45-degree field of view — 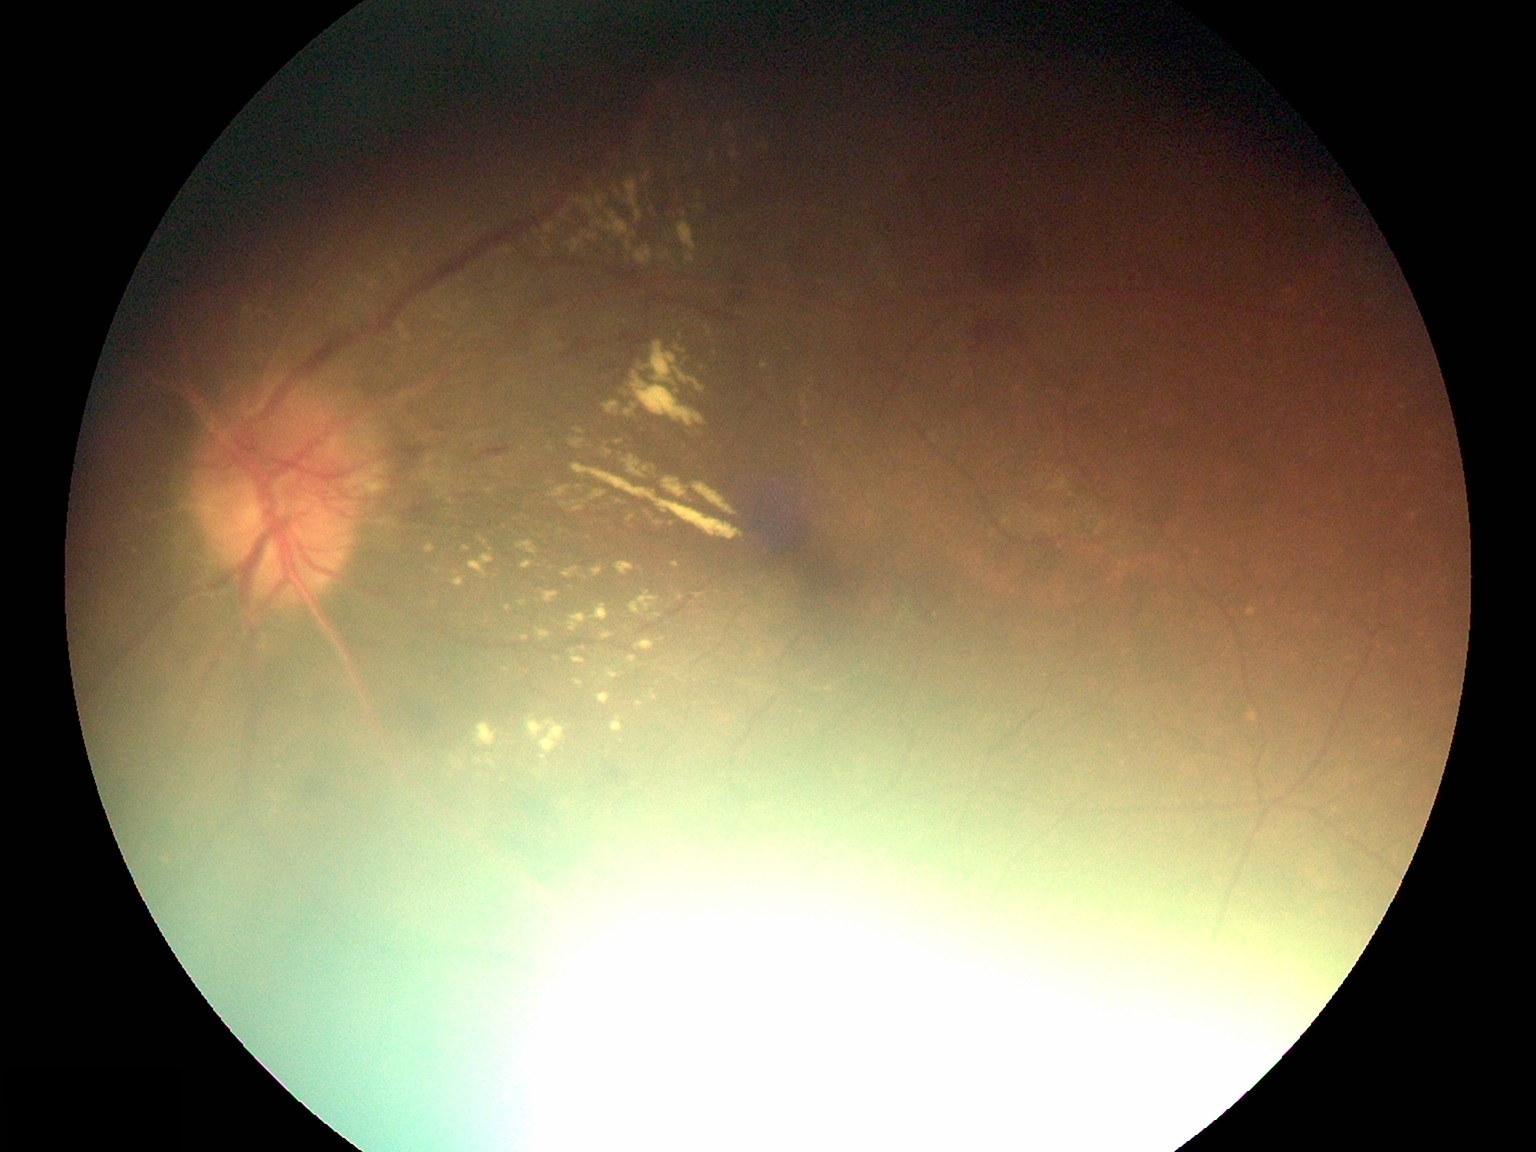
DR stage: proliferative diabetic retinopathy (grade 4).